Pediatric wide-field fundus photograph:
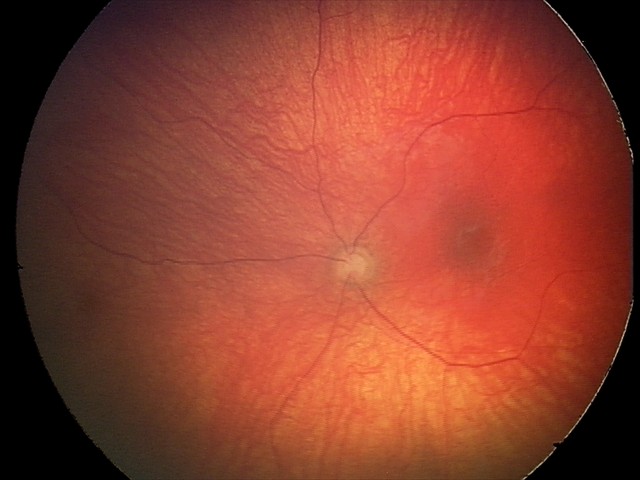

From an examination with diagnosis of optic nerve hypoplasia.